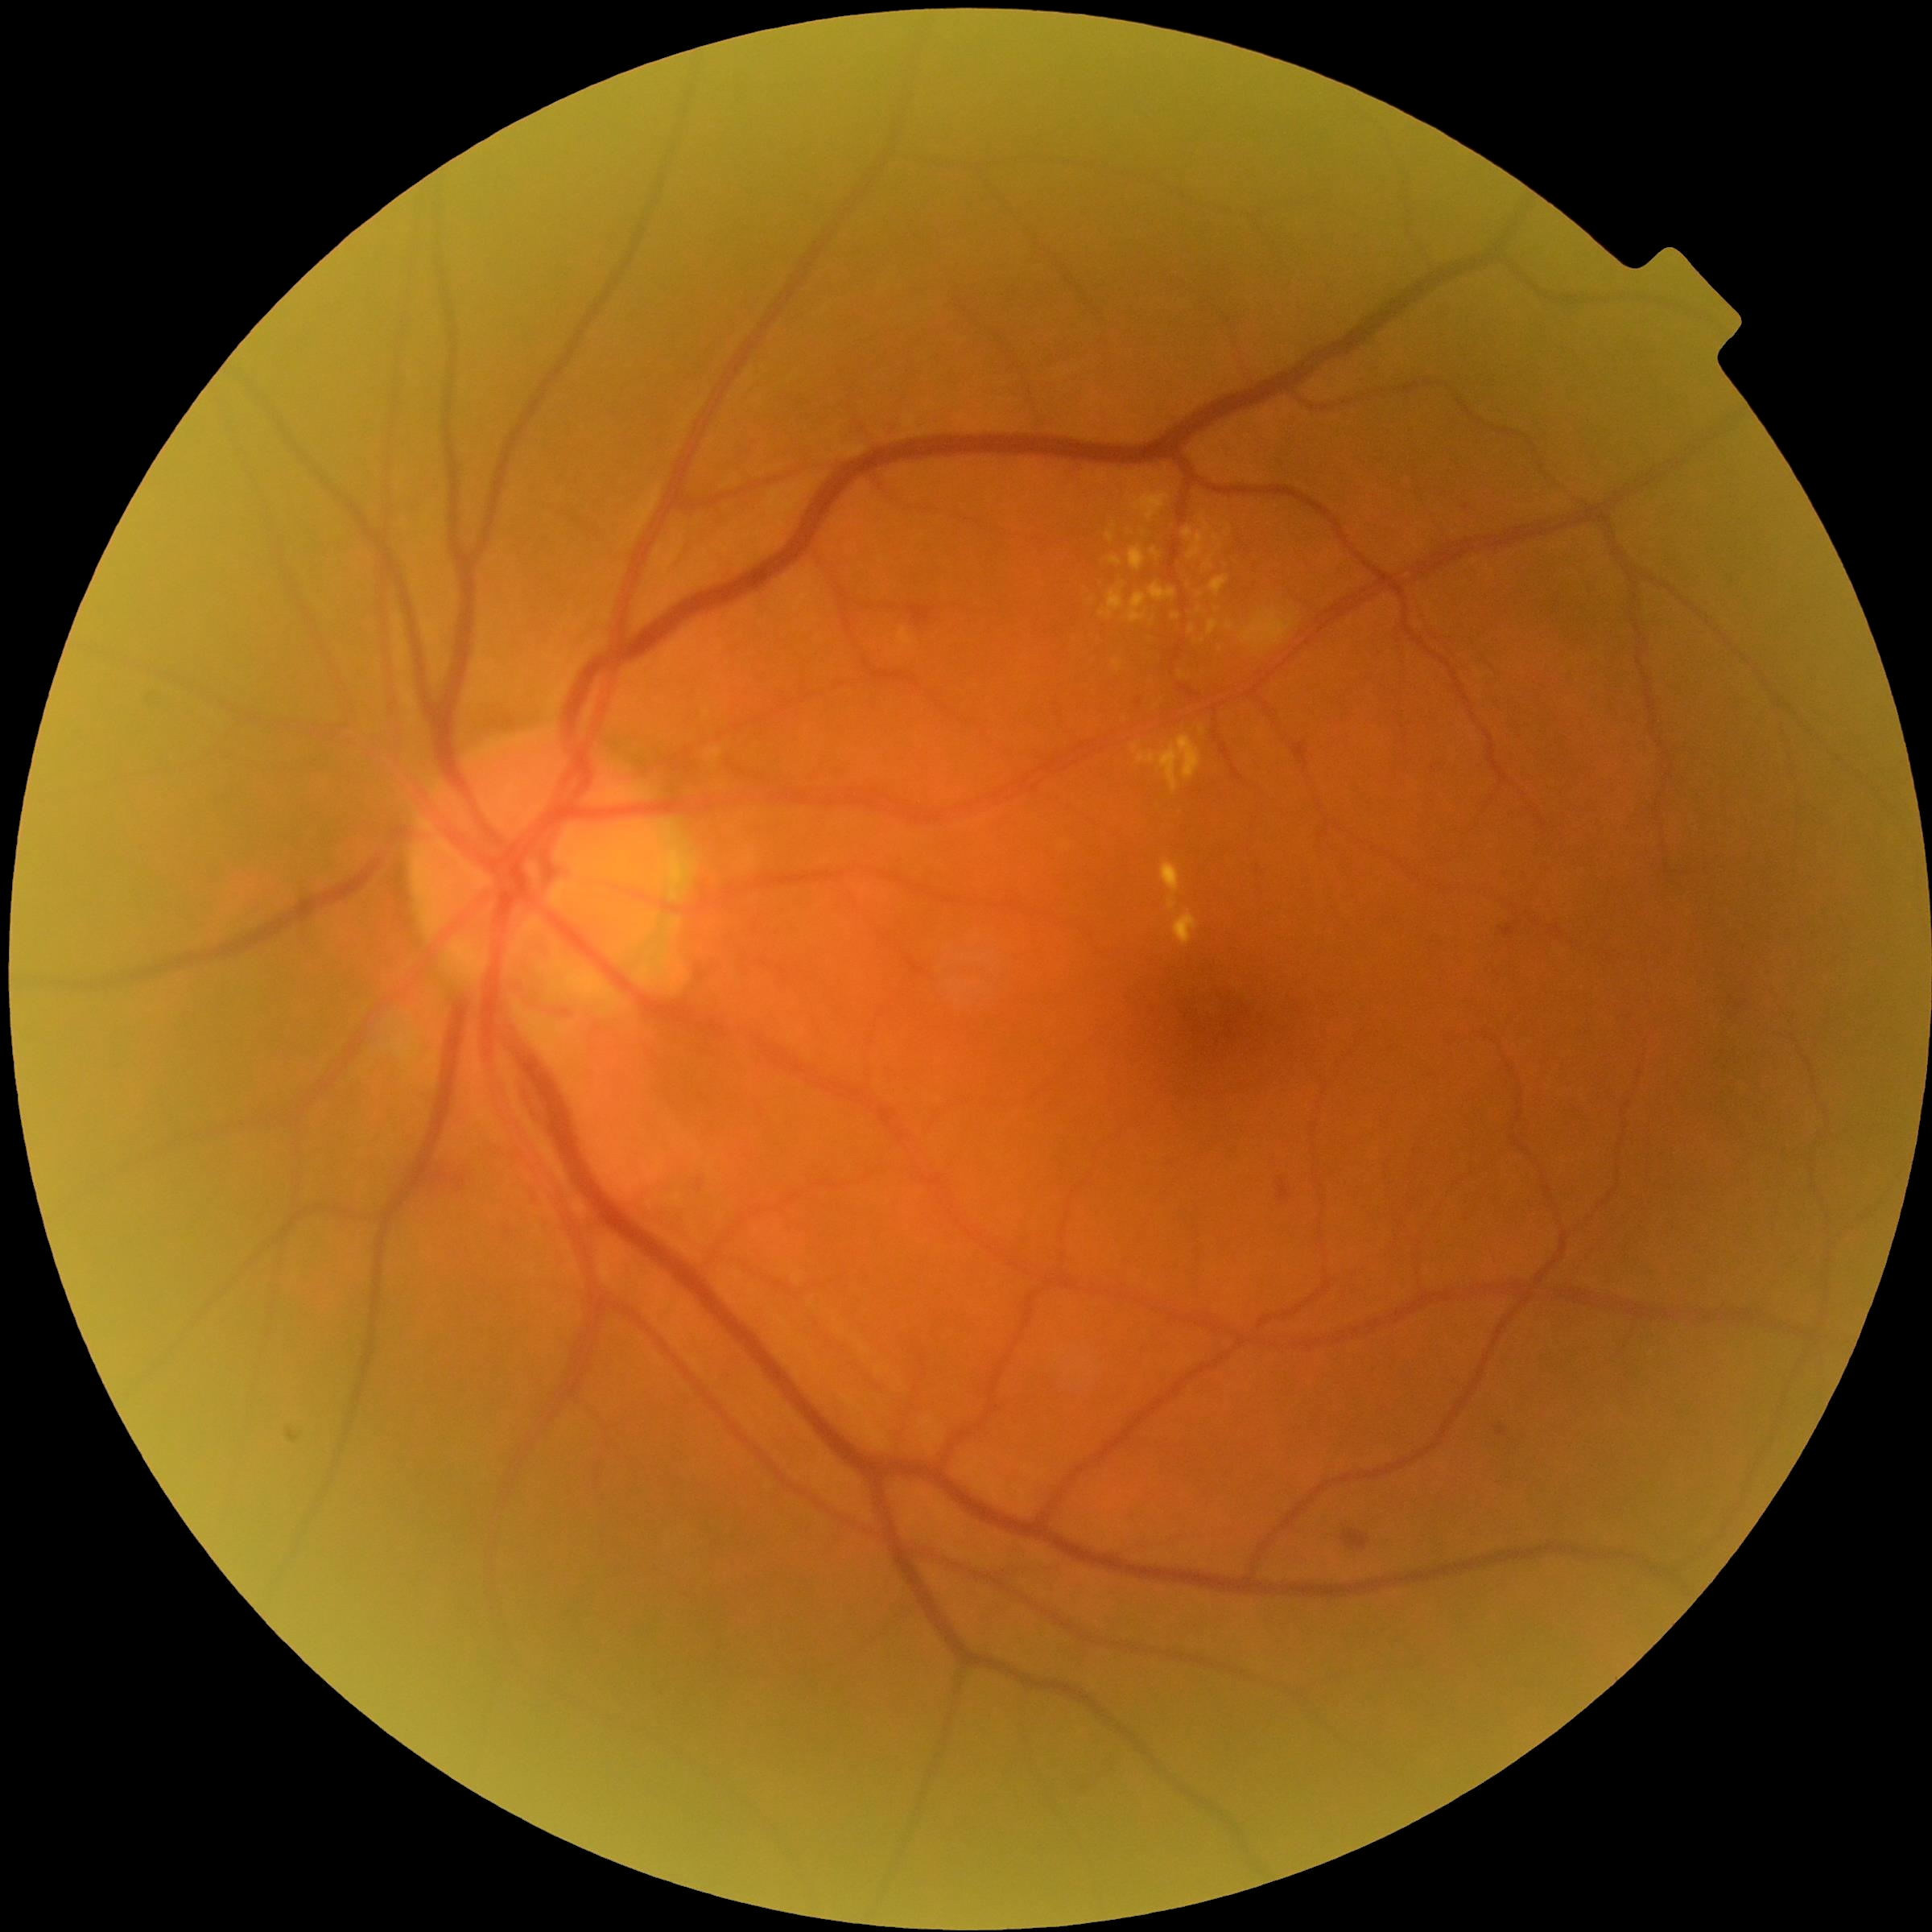 Diabetic retinopathy (DR): moderate non-proliferative diabetic retinopathy (grade 2).
Microaneurysms (MAs) are located at [1499,1426,1506,1436], [1503,926,1516,937].
Hard exudates (EXs) include lesions at [1208,621,1220,636], [1183,529,1195,540], [1106,531,1116,543], [1202,518,1212,531], [1133,736,1202,794], [1172,613,1181,621], [1174,910,1198,946], [1150,584,1178,602], [1161,861,1181,914], [1189,533,1203,561].
Additional small EXs near {"x": 1203, "y": 731}, {"x": 1114, "y": 526}, {"x": 1216, "y": 538}.
Hemorrhages (HEs) are located at [909,606,933,627], [1343,1530,1369,1550], [413,1158,464,1198], [1279,1181,1292,1201].
No soft exudates (SEs) identified.